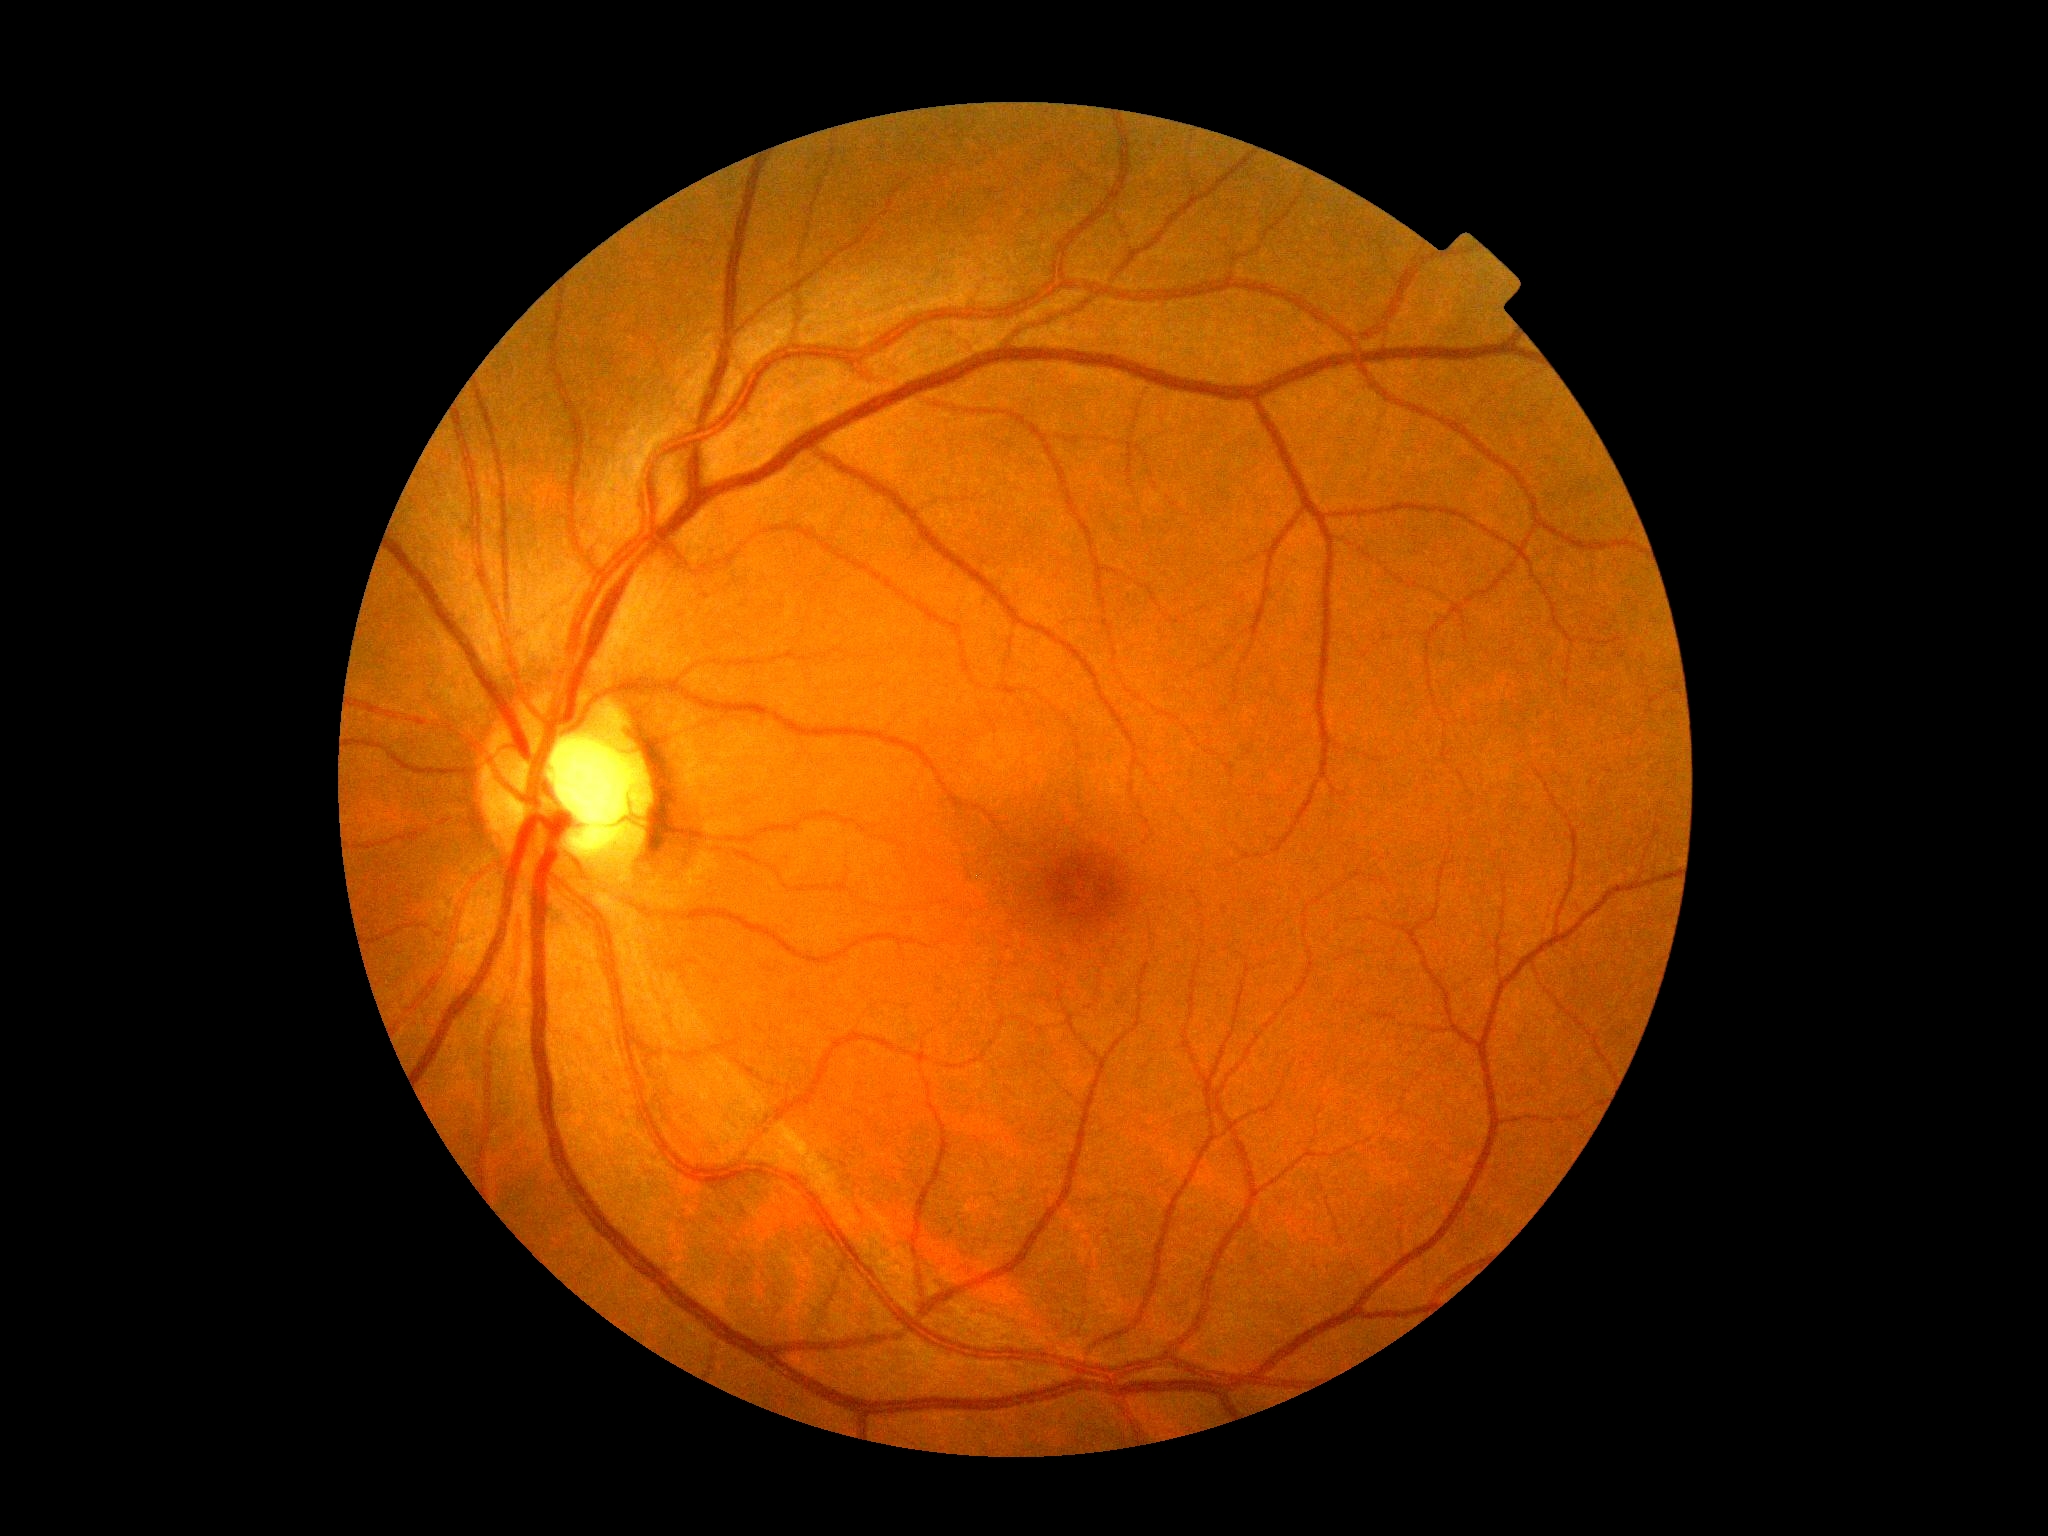 Retinopathy: grade 0 (no apparent retinopathy).